FOV: 45 degrees
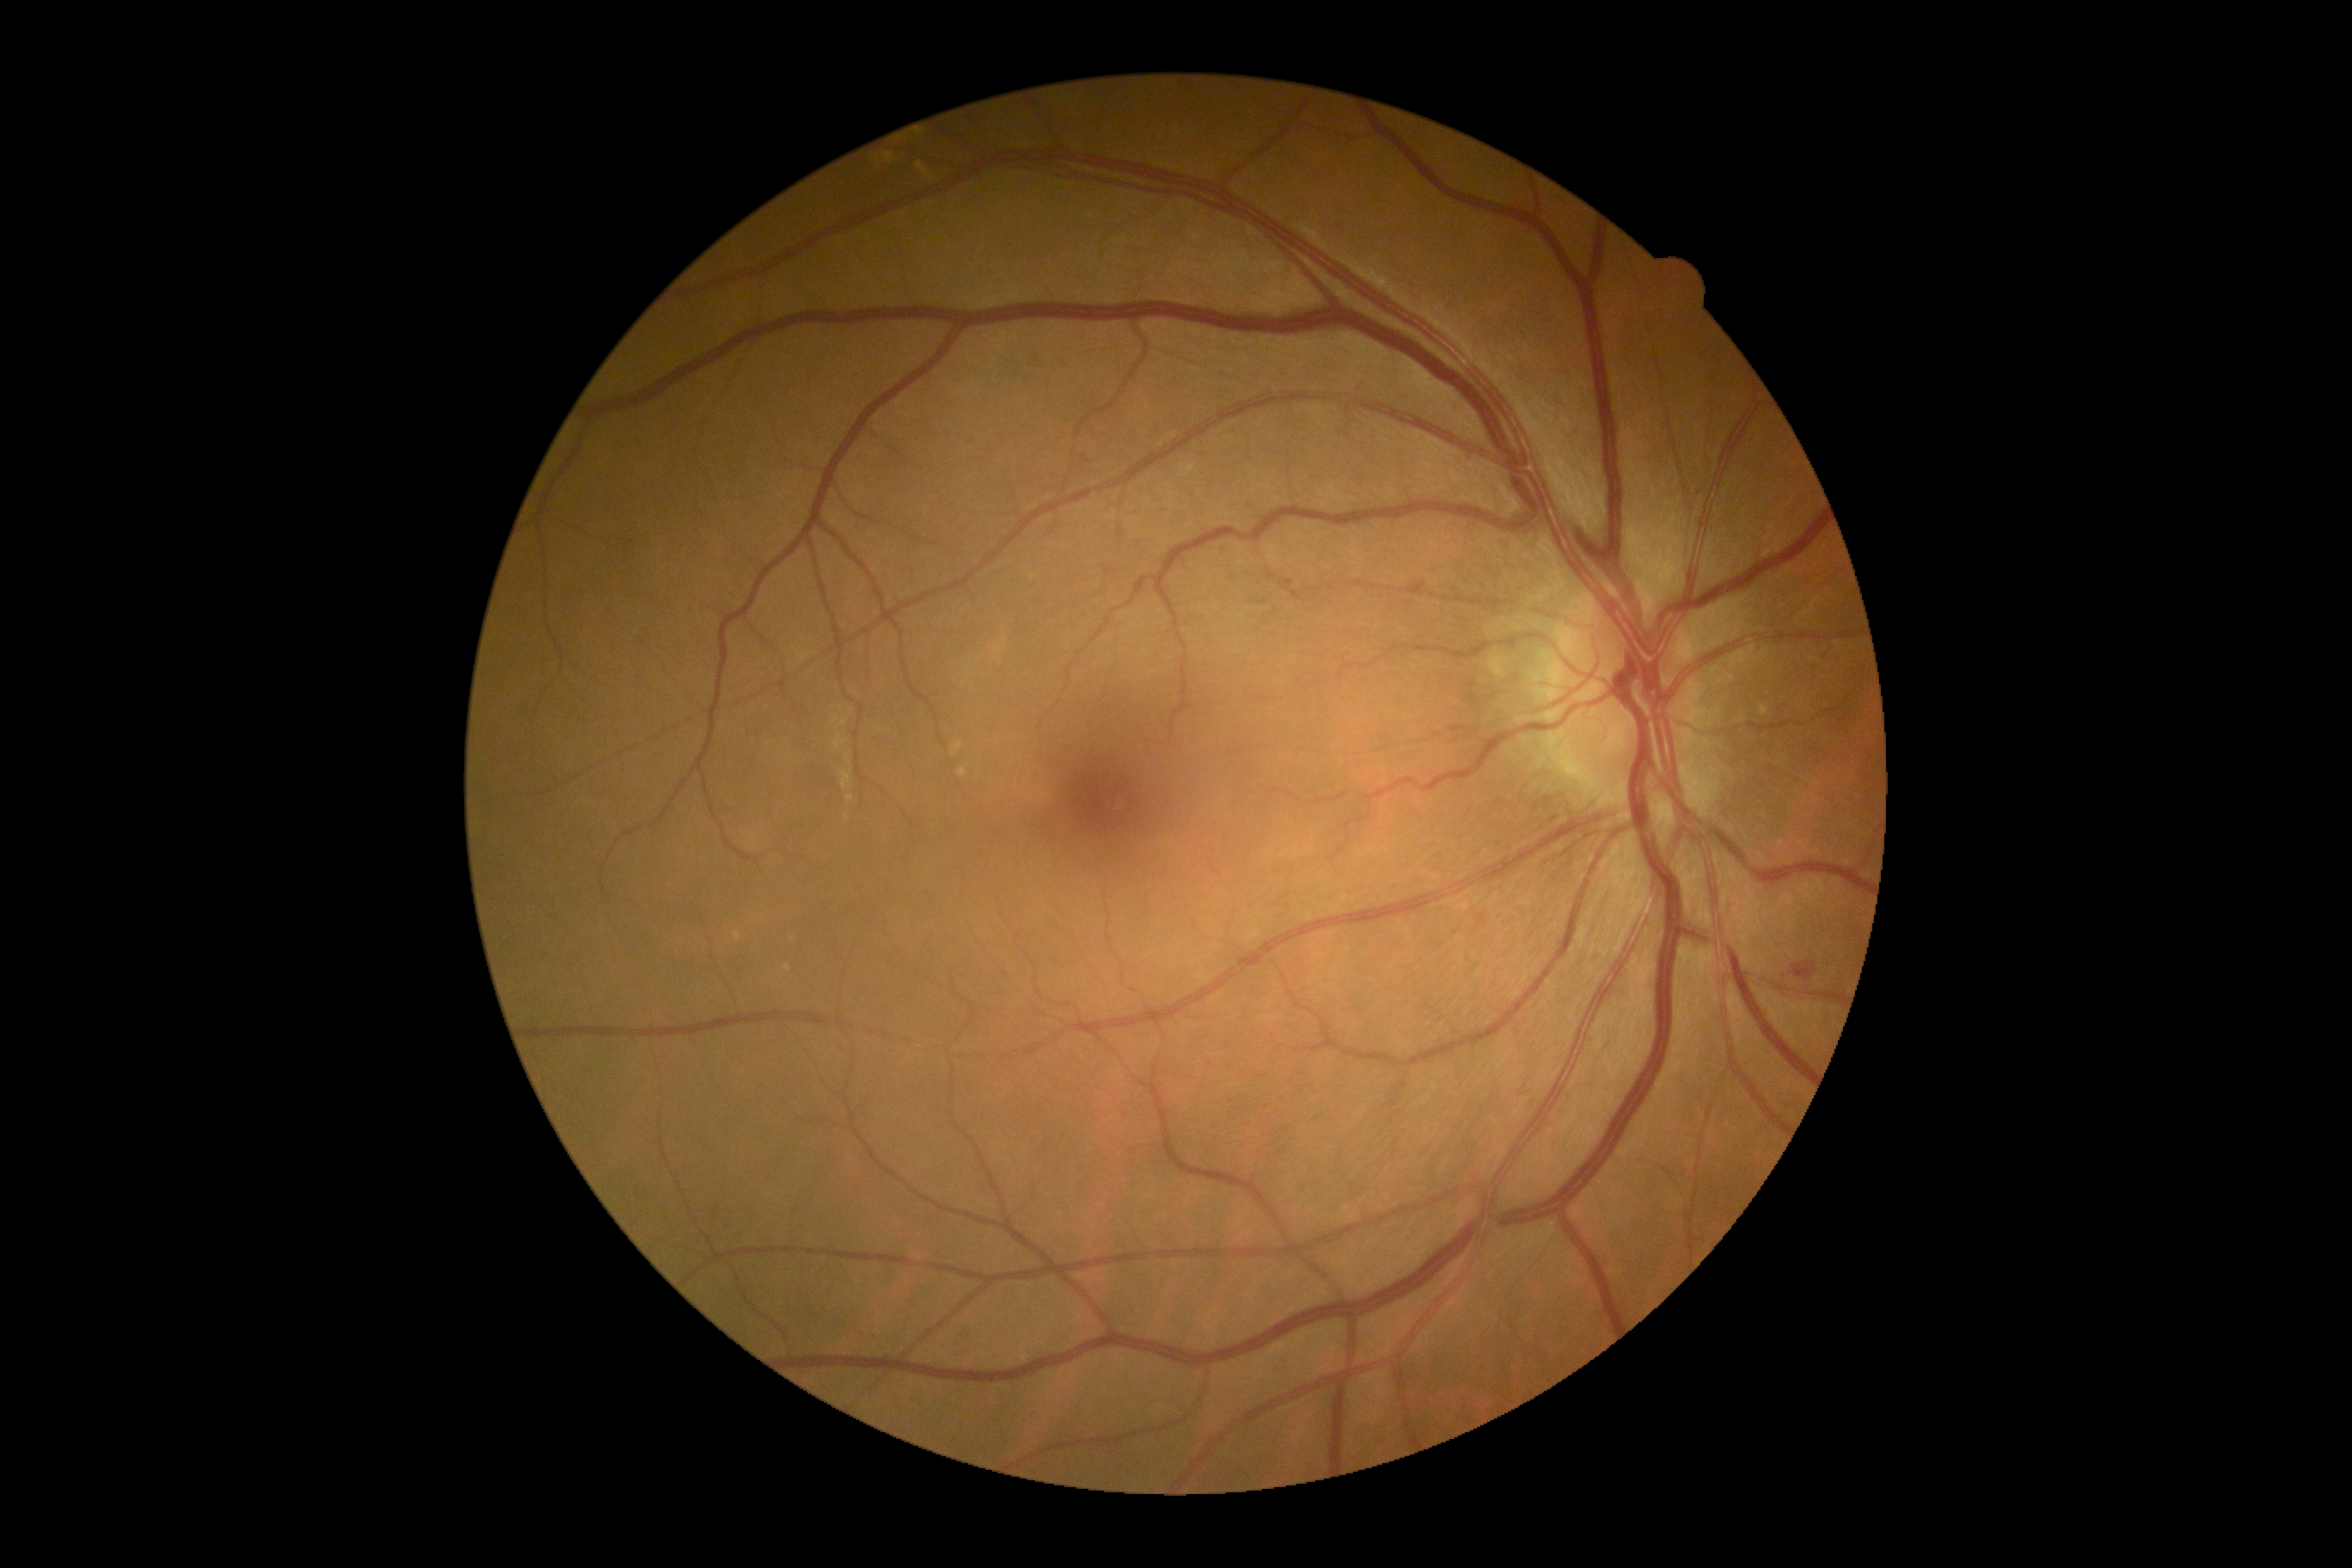

DR: moderate non-proliferative diabetic retinopathy (grade 2).